45° field of view. Retinal fundus photograph — 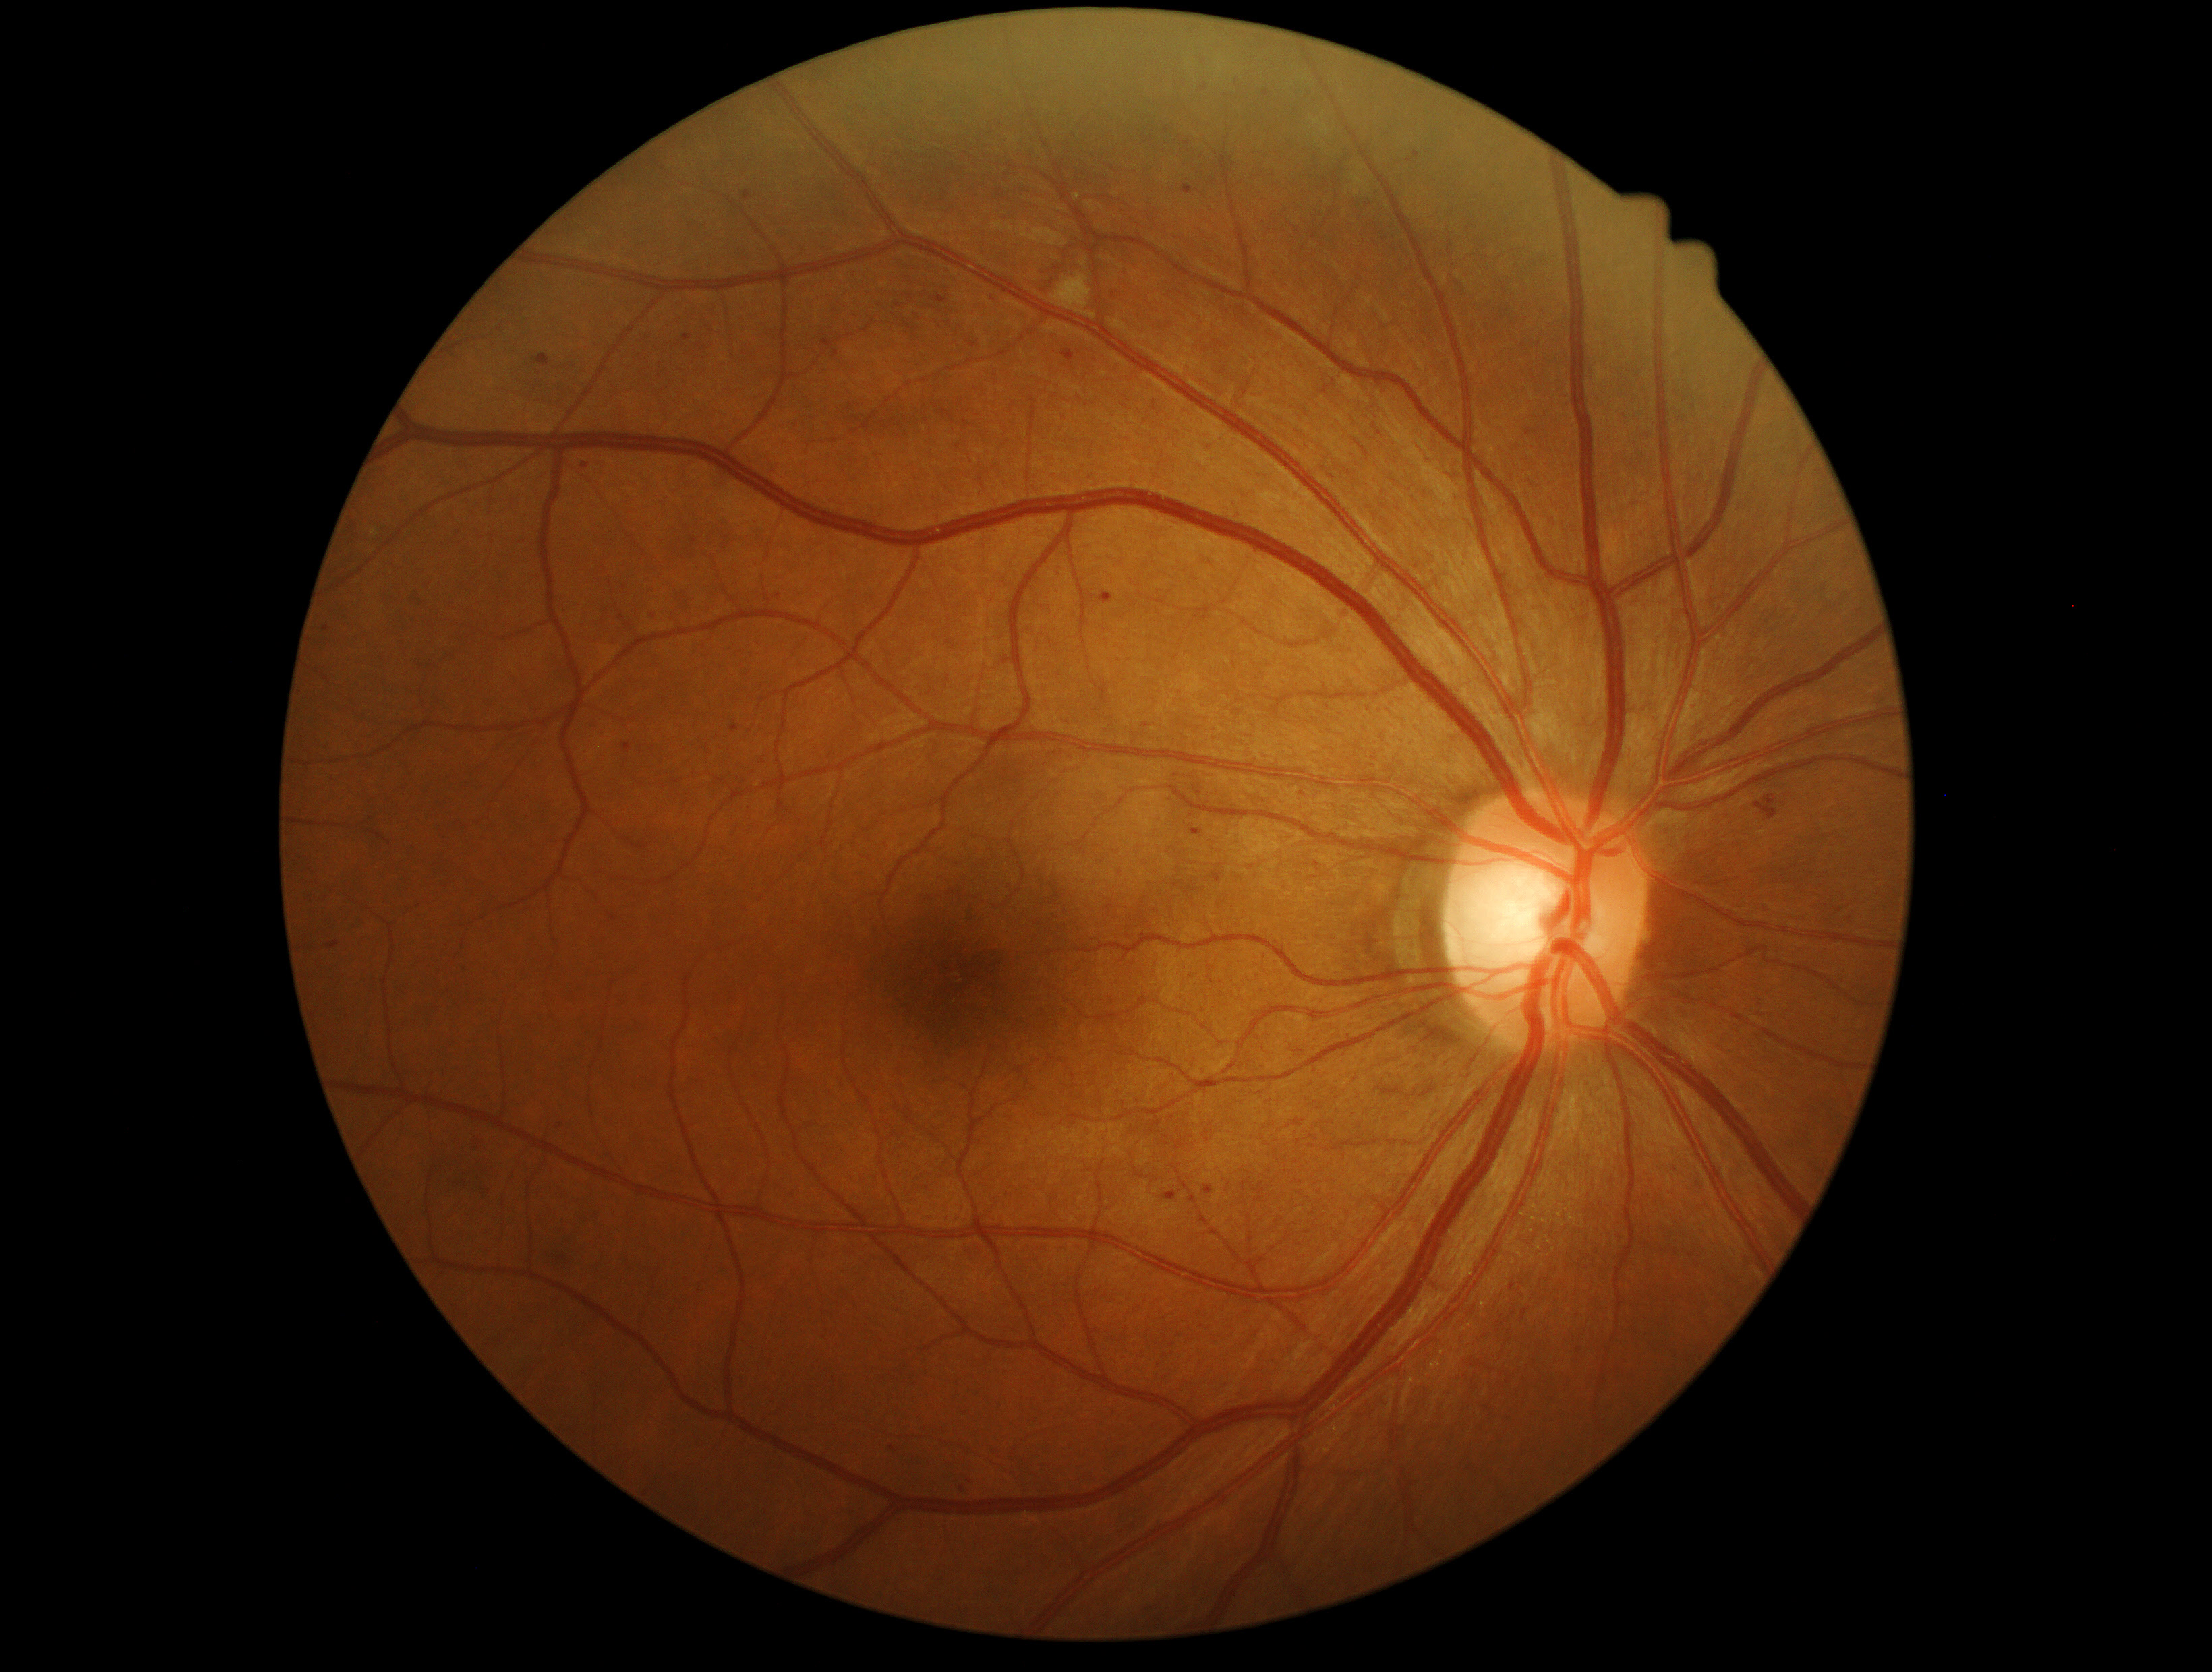 {"partial":true,"dr_grade":2,"lesions":{"ex":null,"se":[[1051,273,1096,319]],"ma":[[1413,152,1421,160],[1100,594,1112,603],[691,537,697,548],[931,296,949,304],[1190,829,1201,837],[744,191,753,200],[532,354,550,367],[1182,184,1194,196]],"ma_small_centers":[[1410,162],[778,597],[586,466],[654,616],[1205,89]],"he":[[1047,242,1077,289],[1754,795,1778,820]]}}